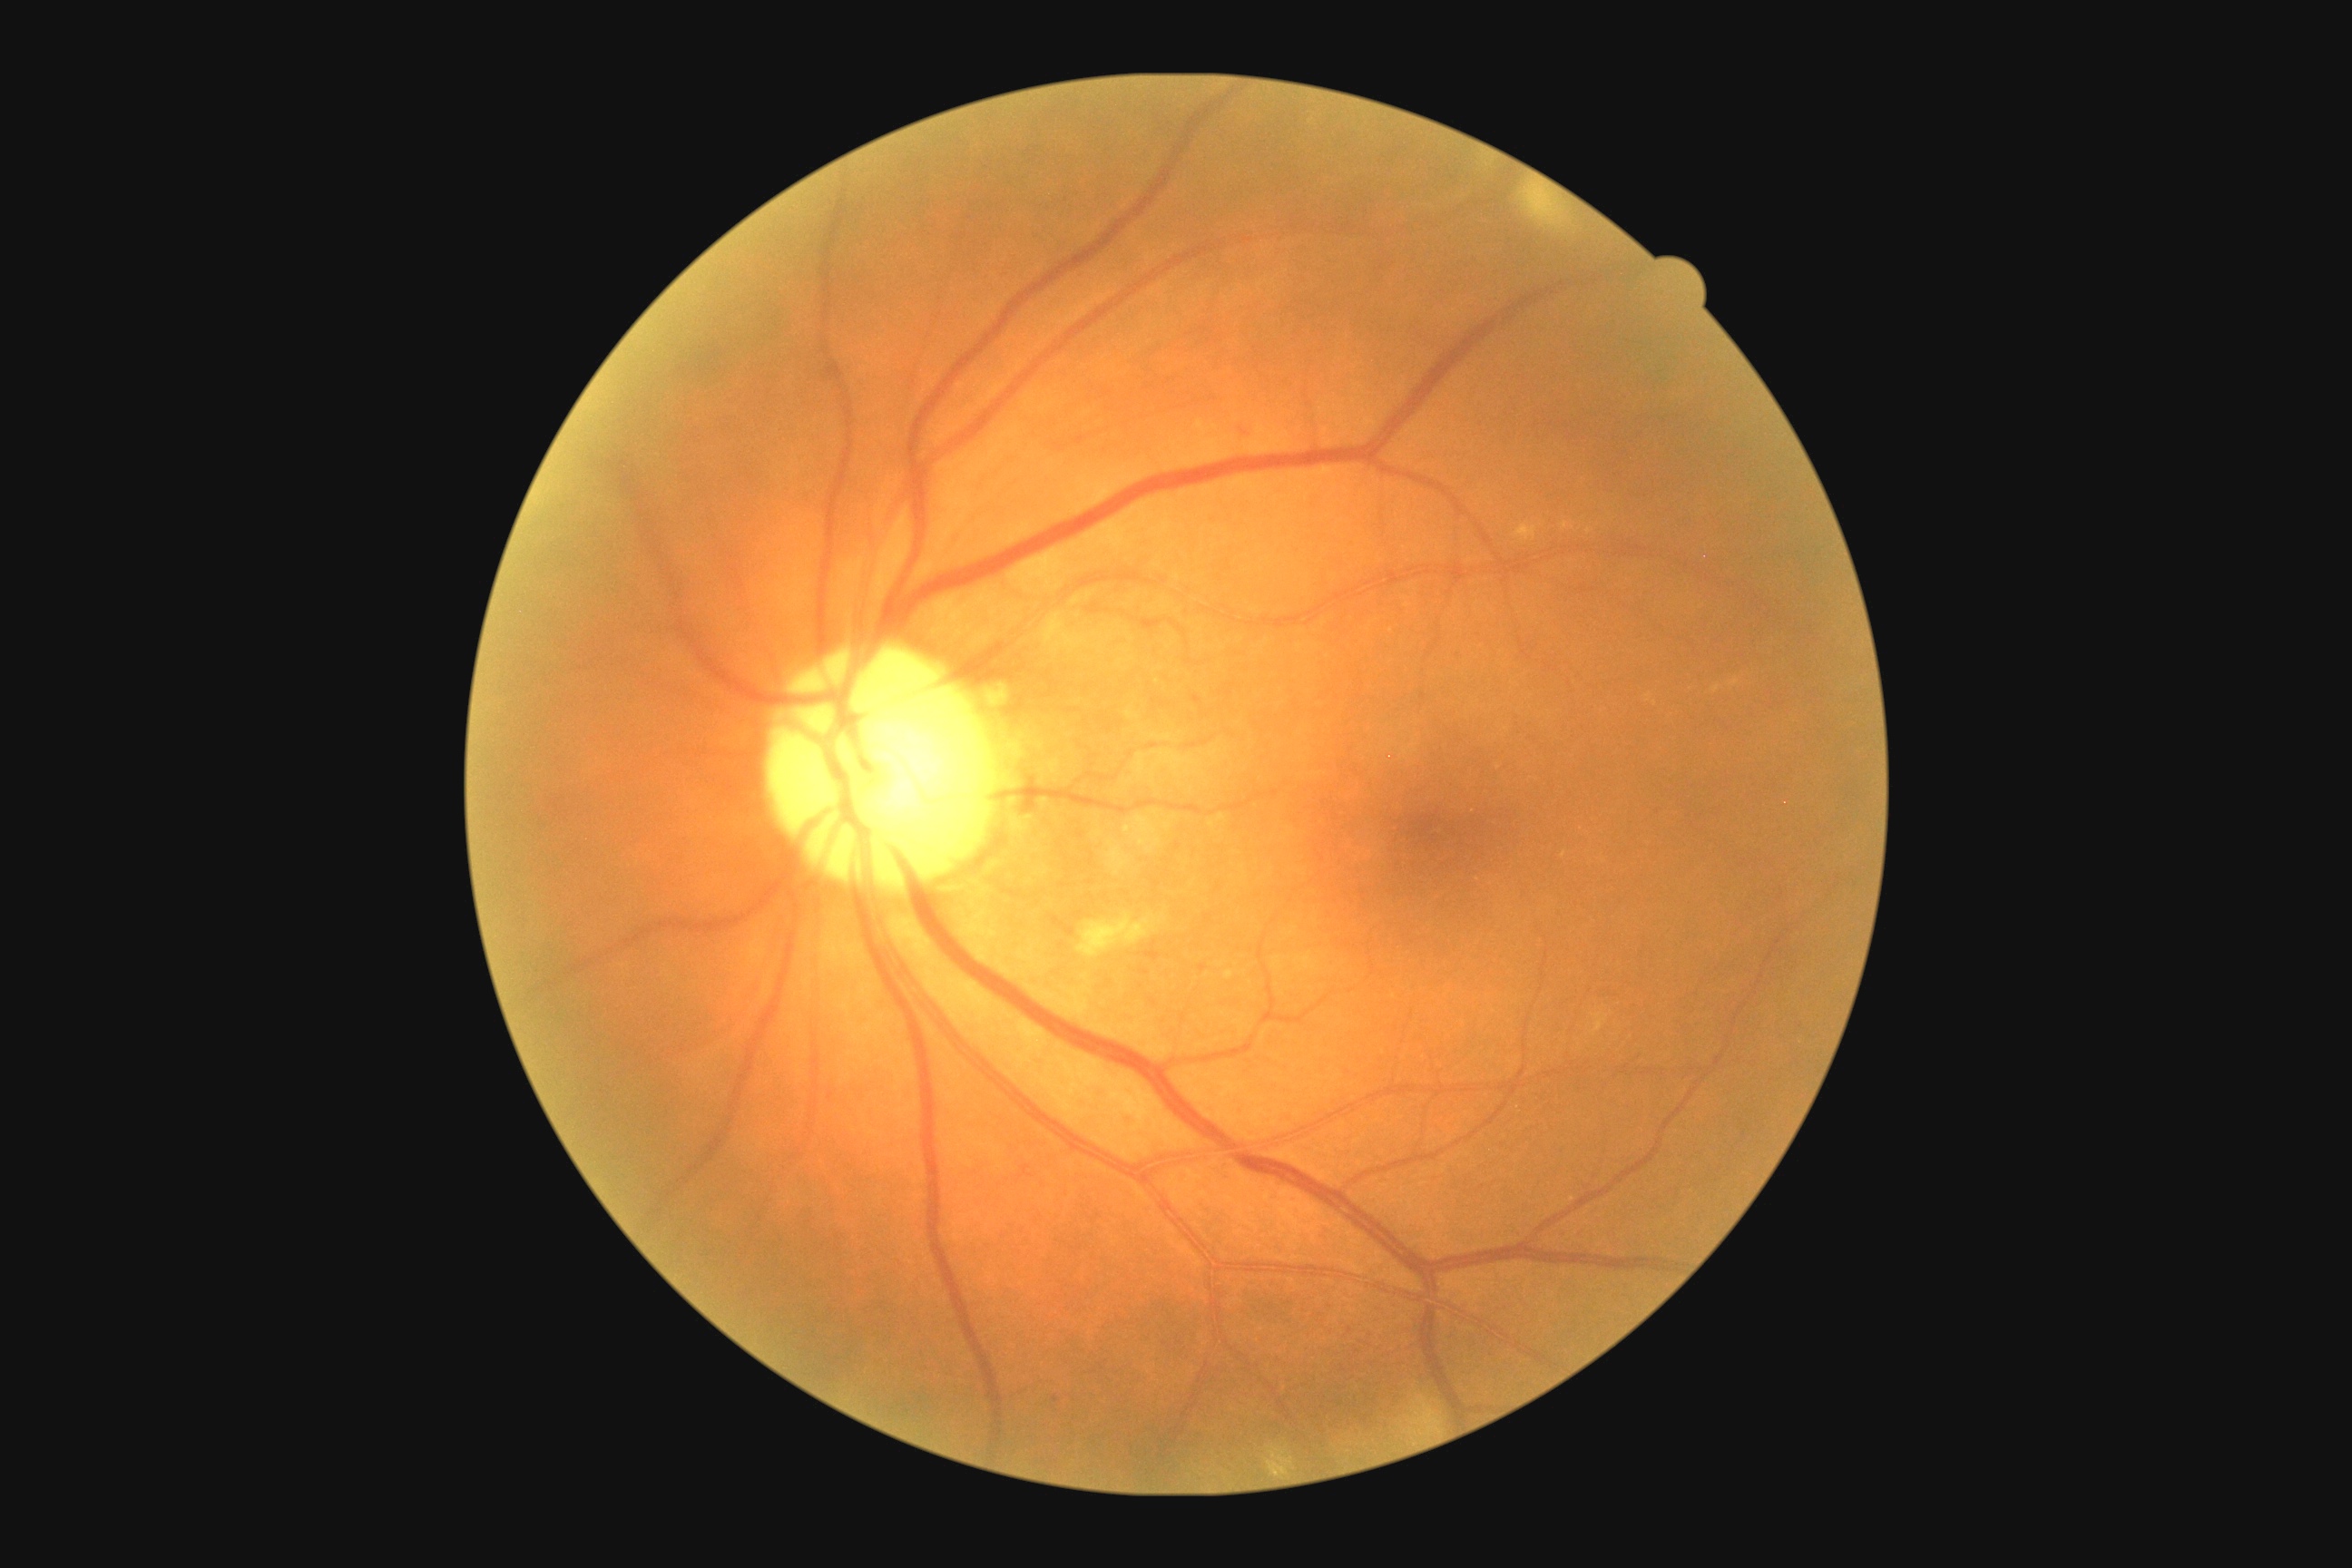
retinopathy grade@moderate NPDR (2); DR class@non-proliferative diabetic retinopathy.